Nonmydriatic · modified Davis classification · 848 x 848 pixels
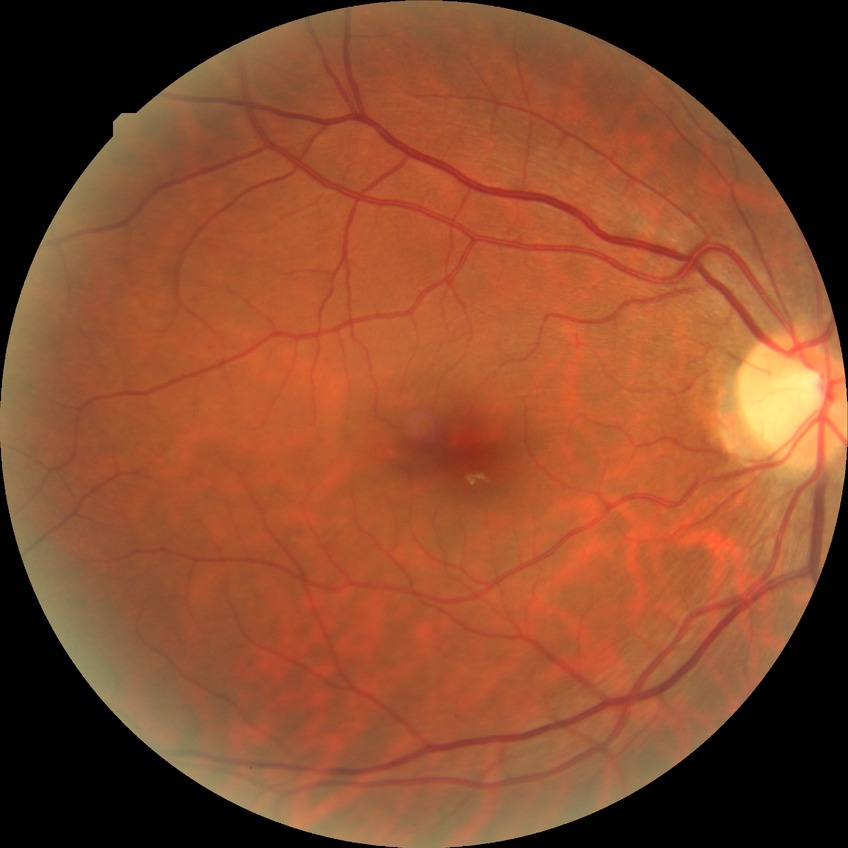
{"davis_grade": "NDR"}